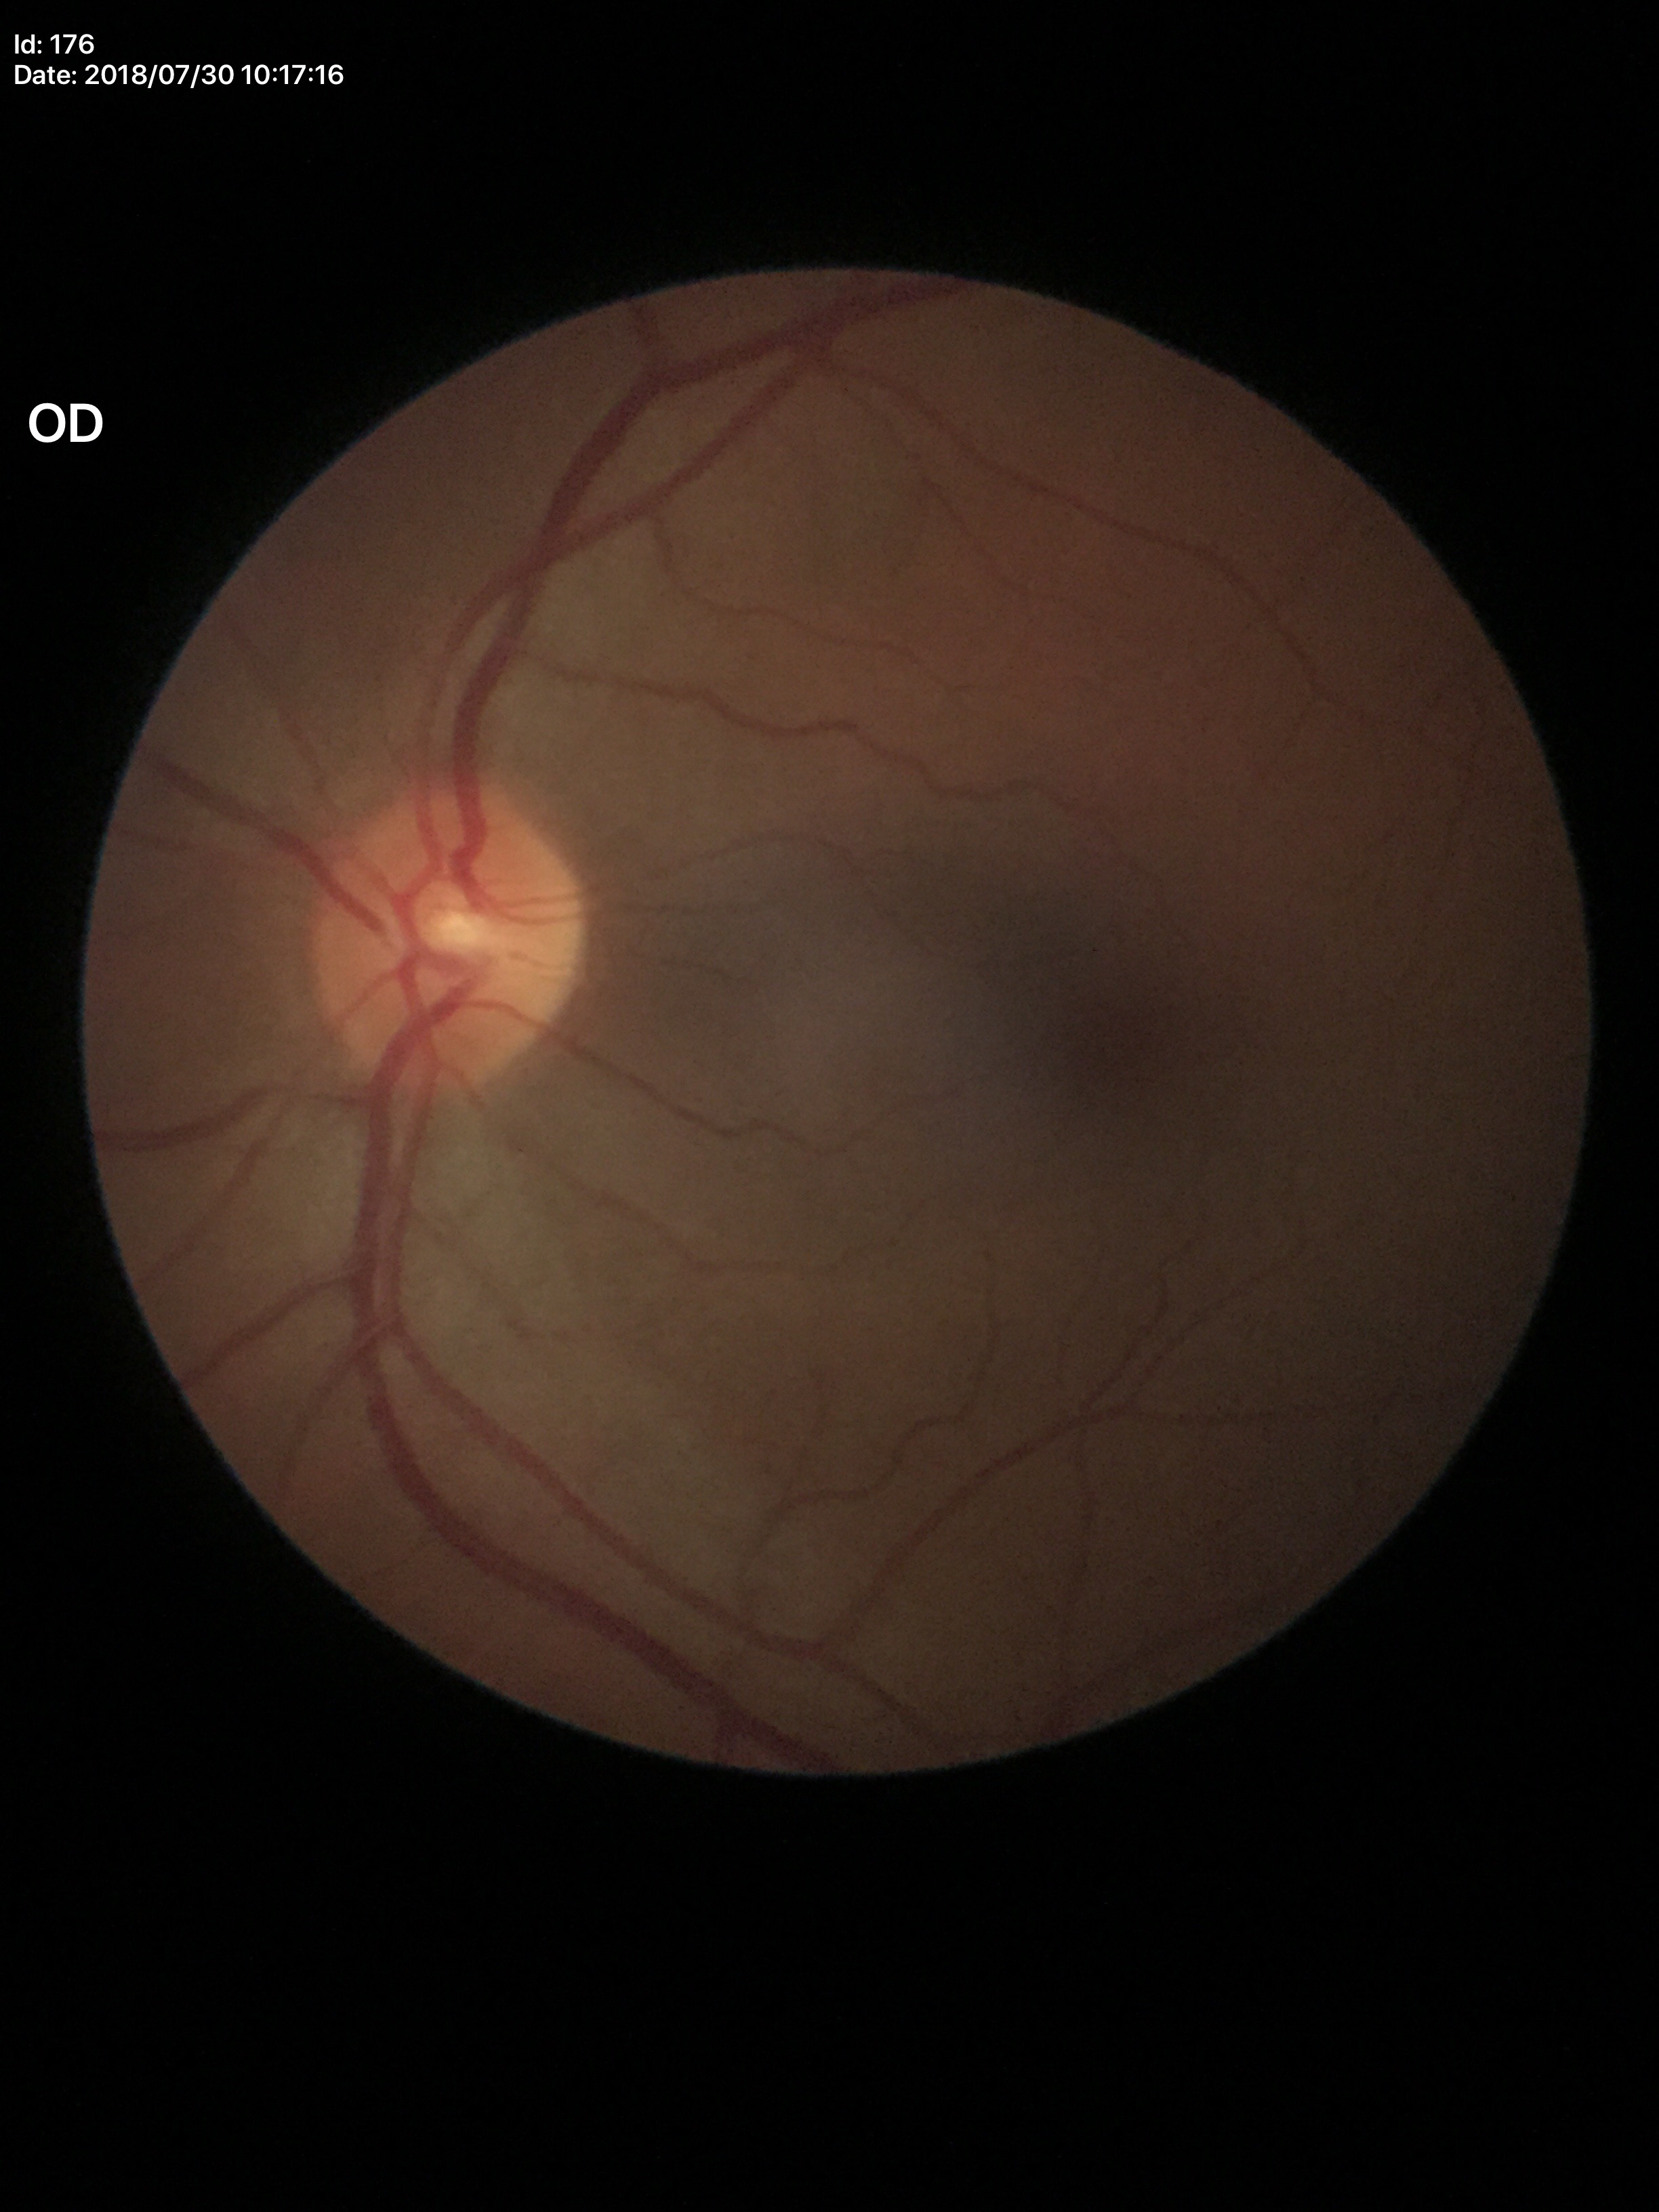
vertical cup-to-disc ratio (VCDR)=0.42 | Glaucoma screening impression=not suspect